2089 by 1764 pixels. CFP.
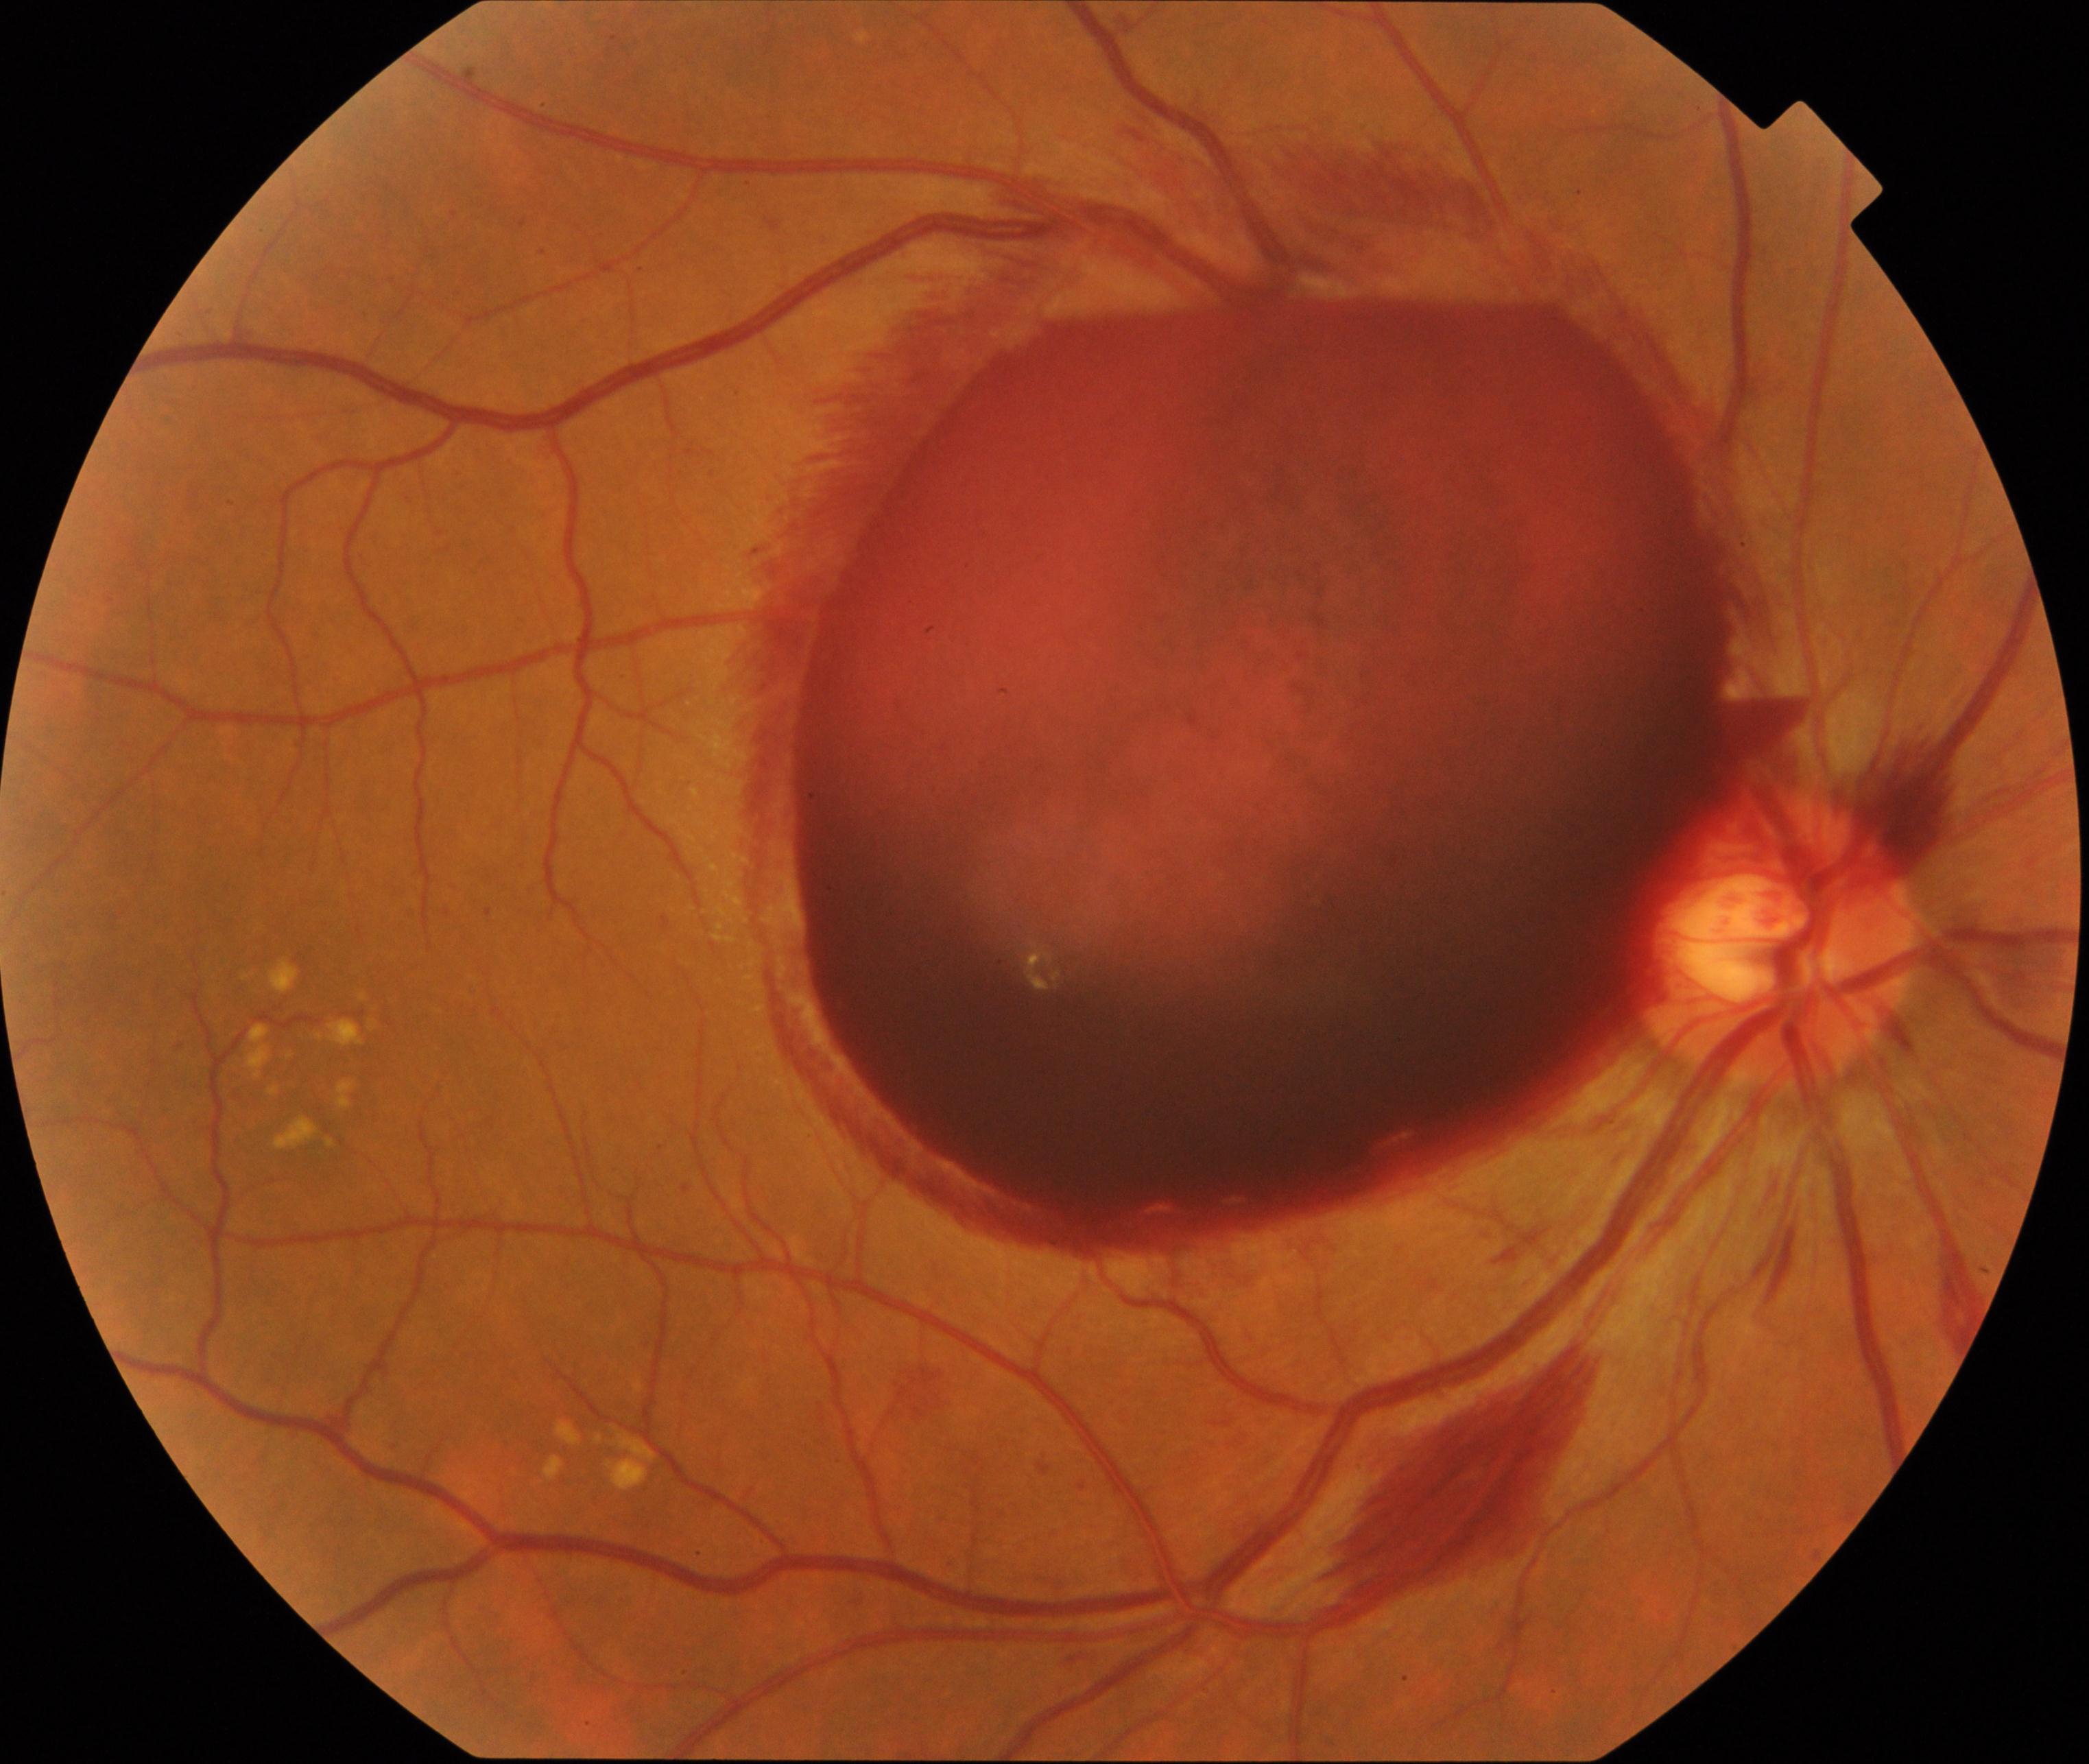 Findings: preretinal hemorrhage.